Image size 2048x1536 · color fundus image.
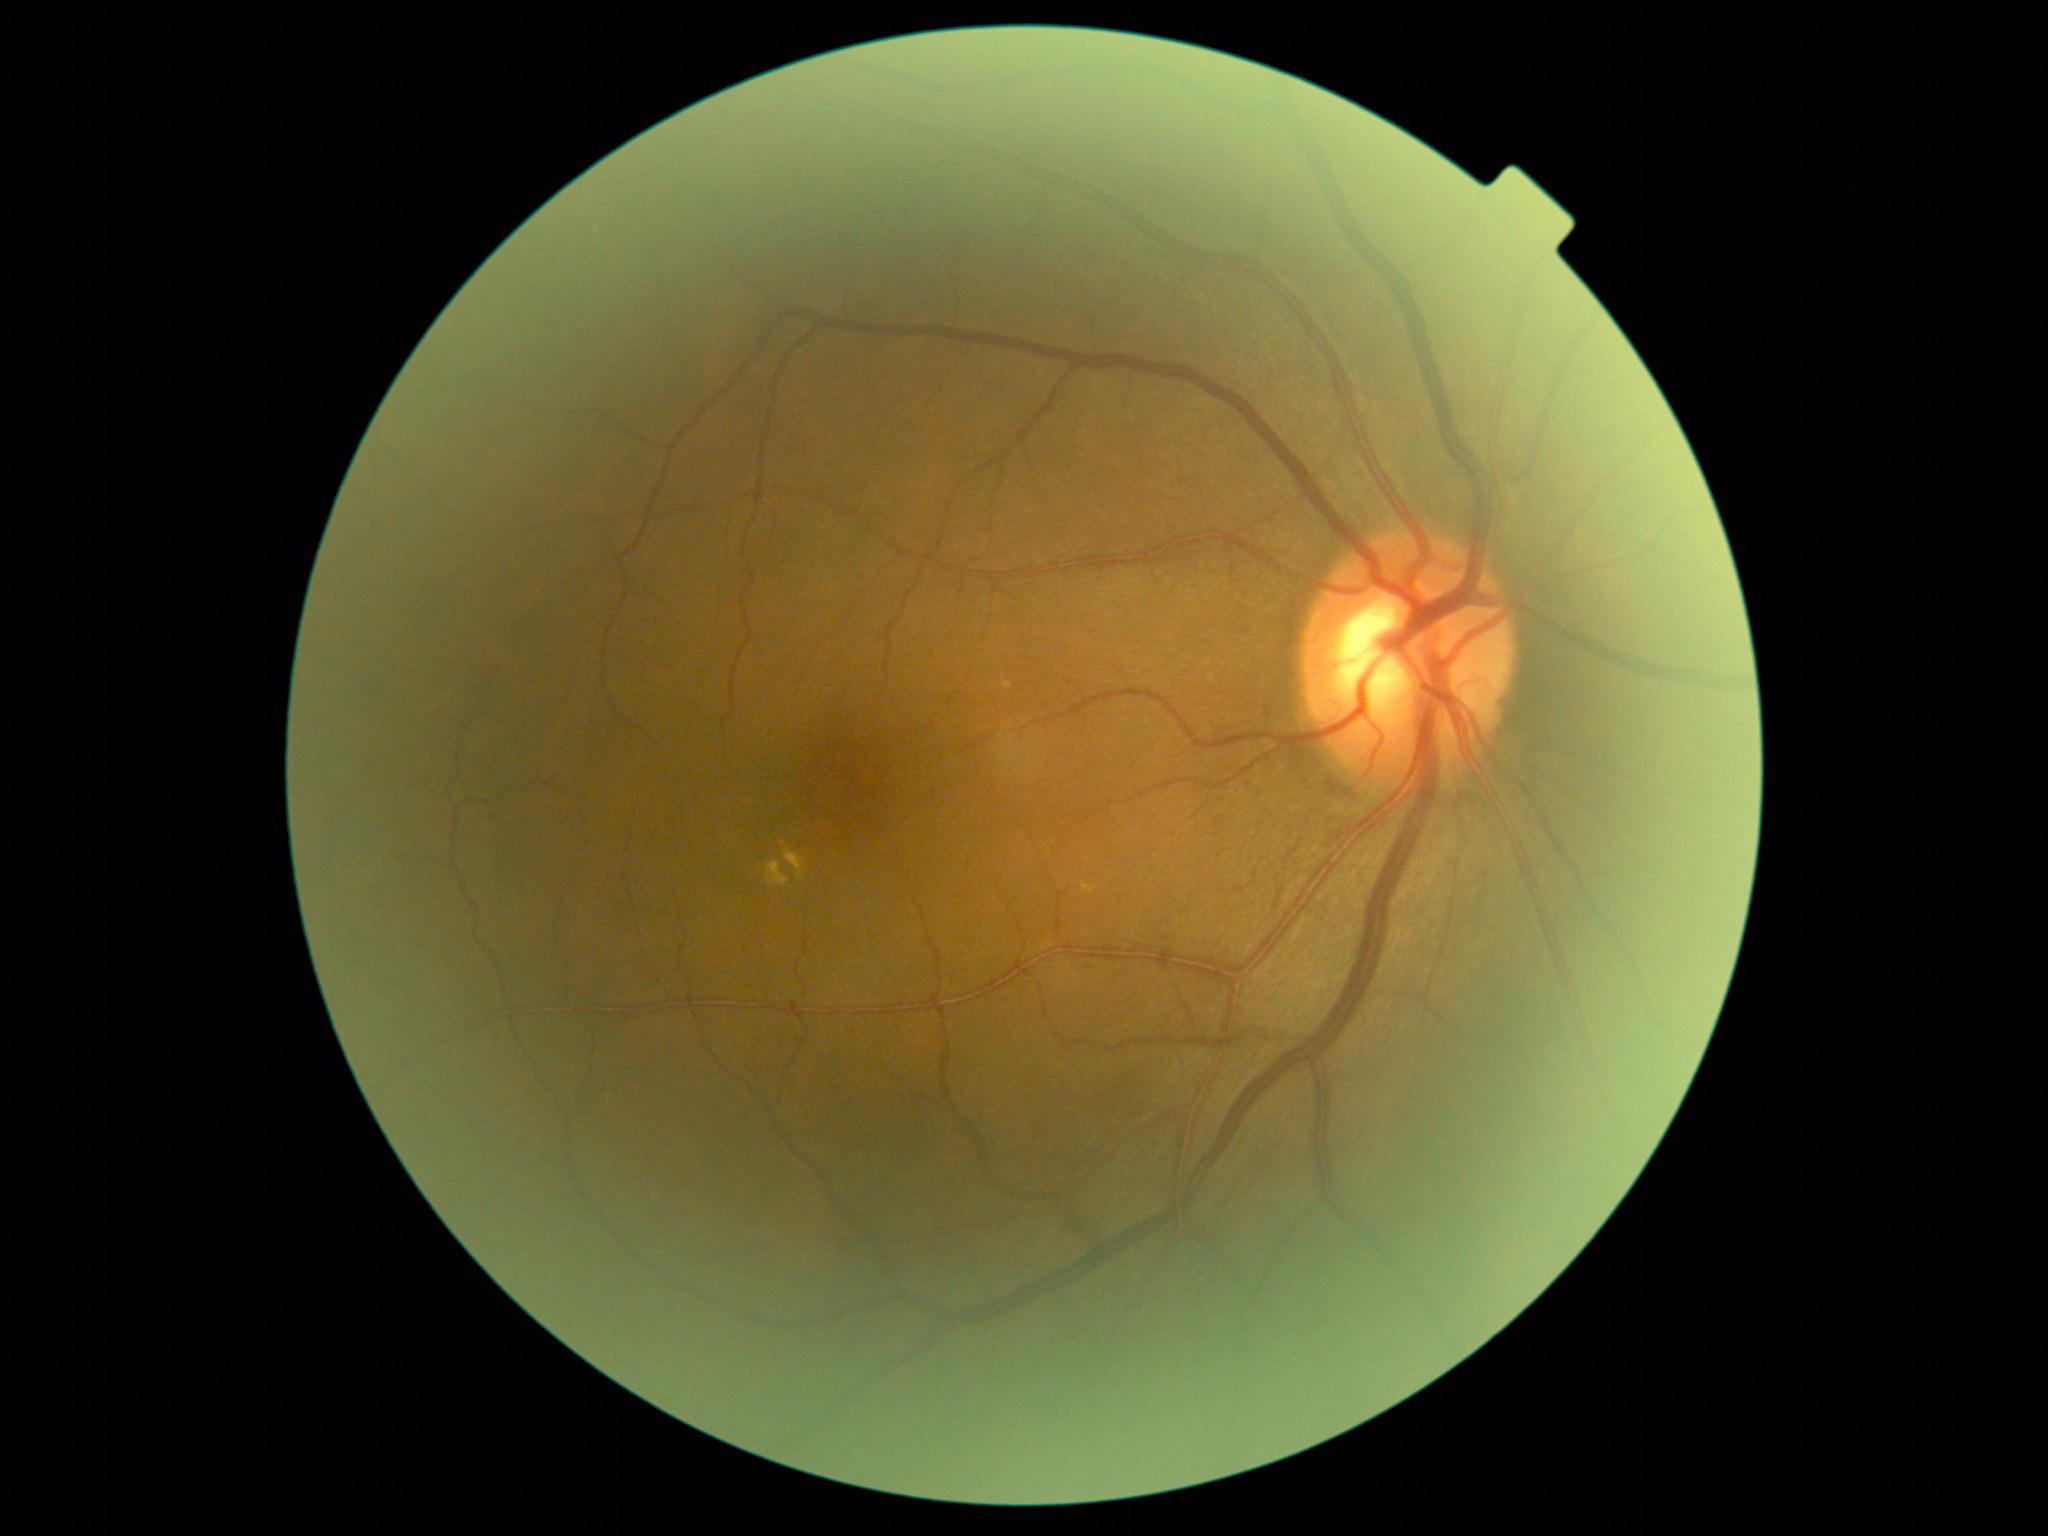

Diabetic retinopathy severity: moderate non-proliferative diabetic retinopathy (grade 2).